640x480; wide-field fundus photograph of an infant
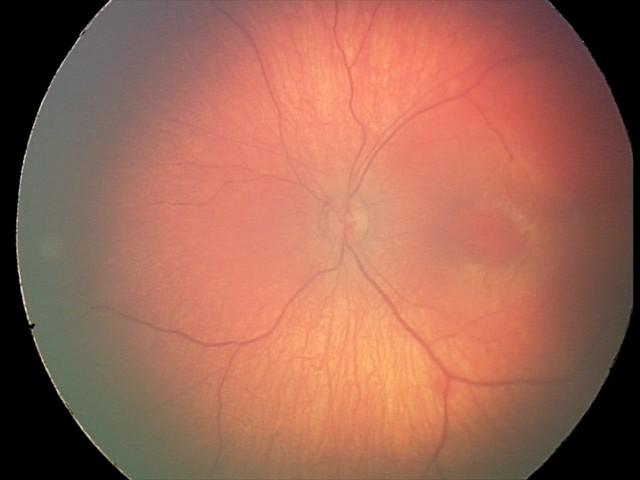 Impression: retinal hemorrhages.